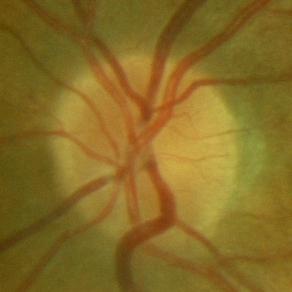 There is evidence of no glaucomatous optic neuropathy.